1659 x 2212 pixels · camera: Remidio FOP fundus camera · retinal fundus photograph.
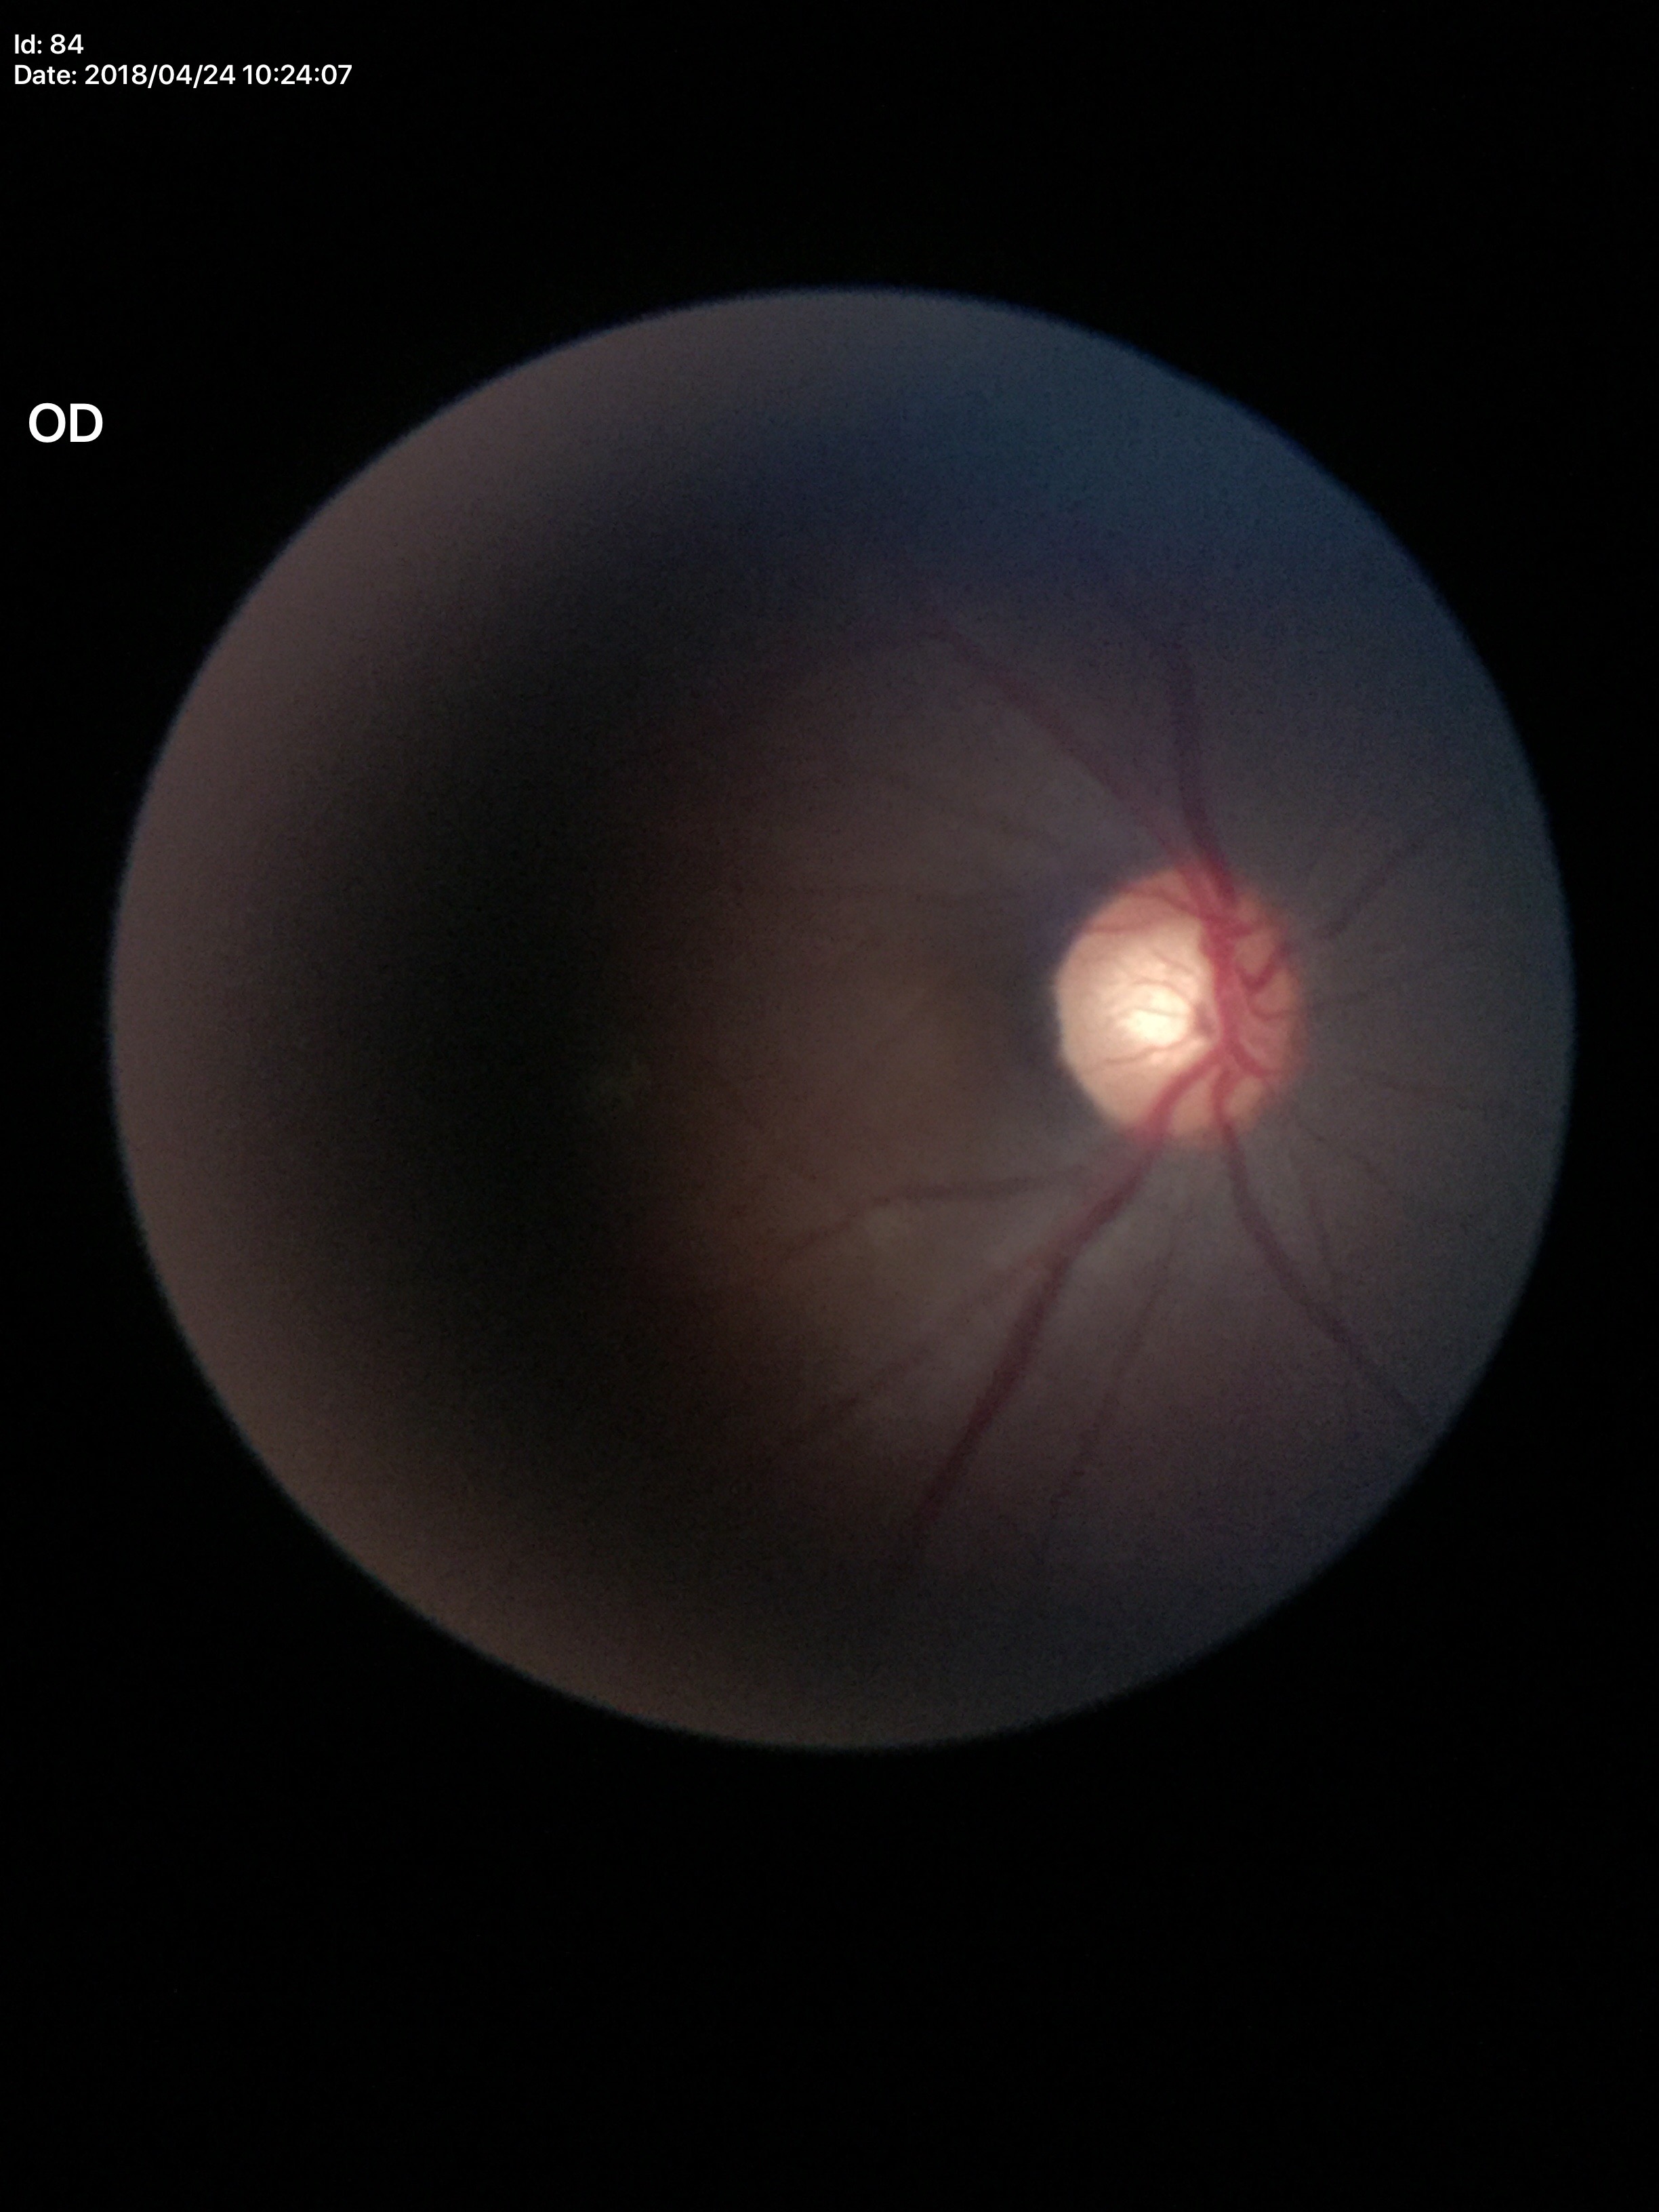
Glaucoma assessment: no suspicious findings (2/5 graders called glaucoma suspect). Vertical CDR is 0.59.